Image size 2212x1659:
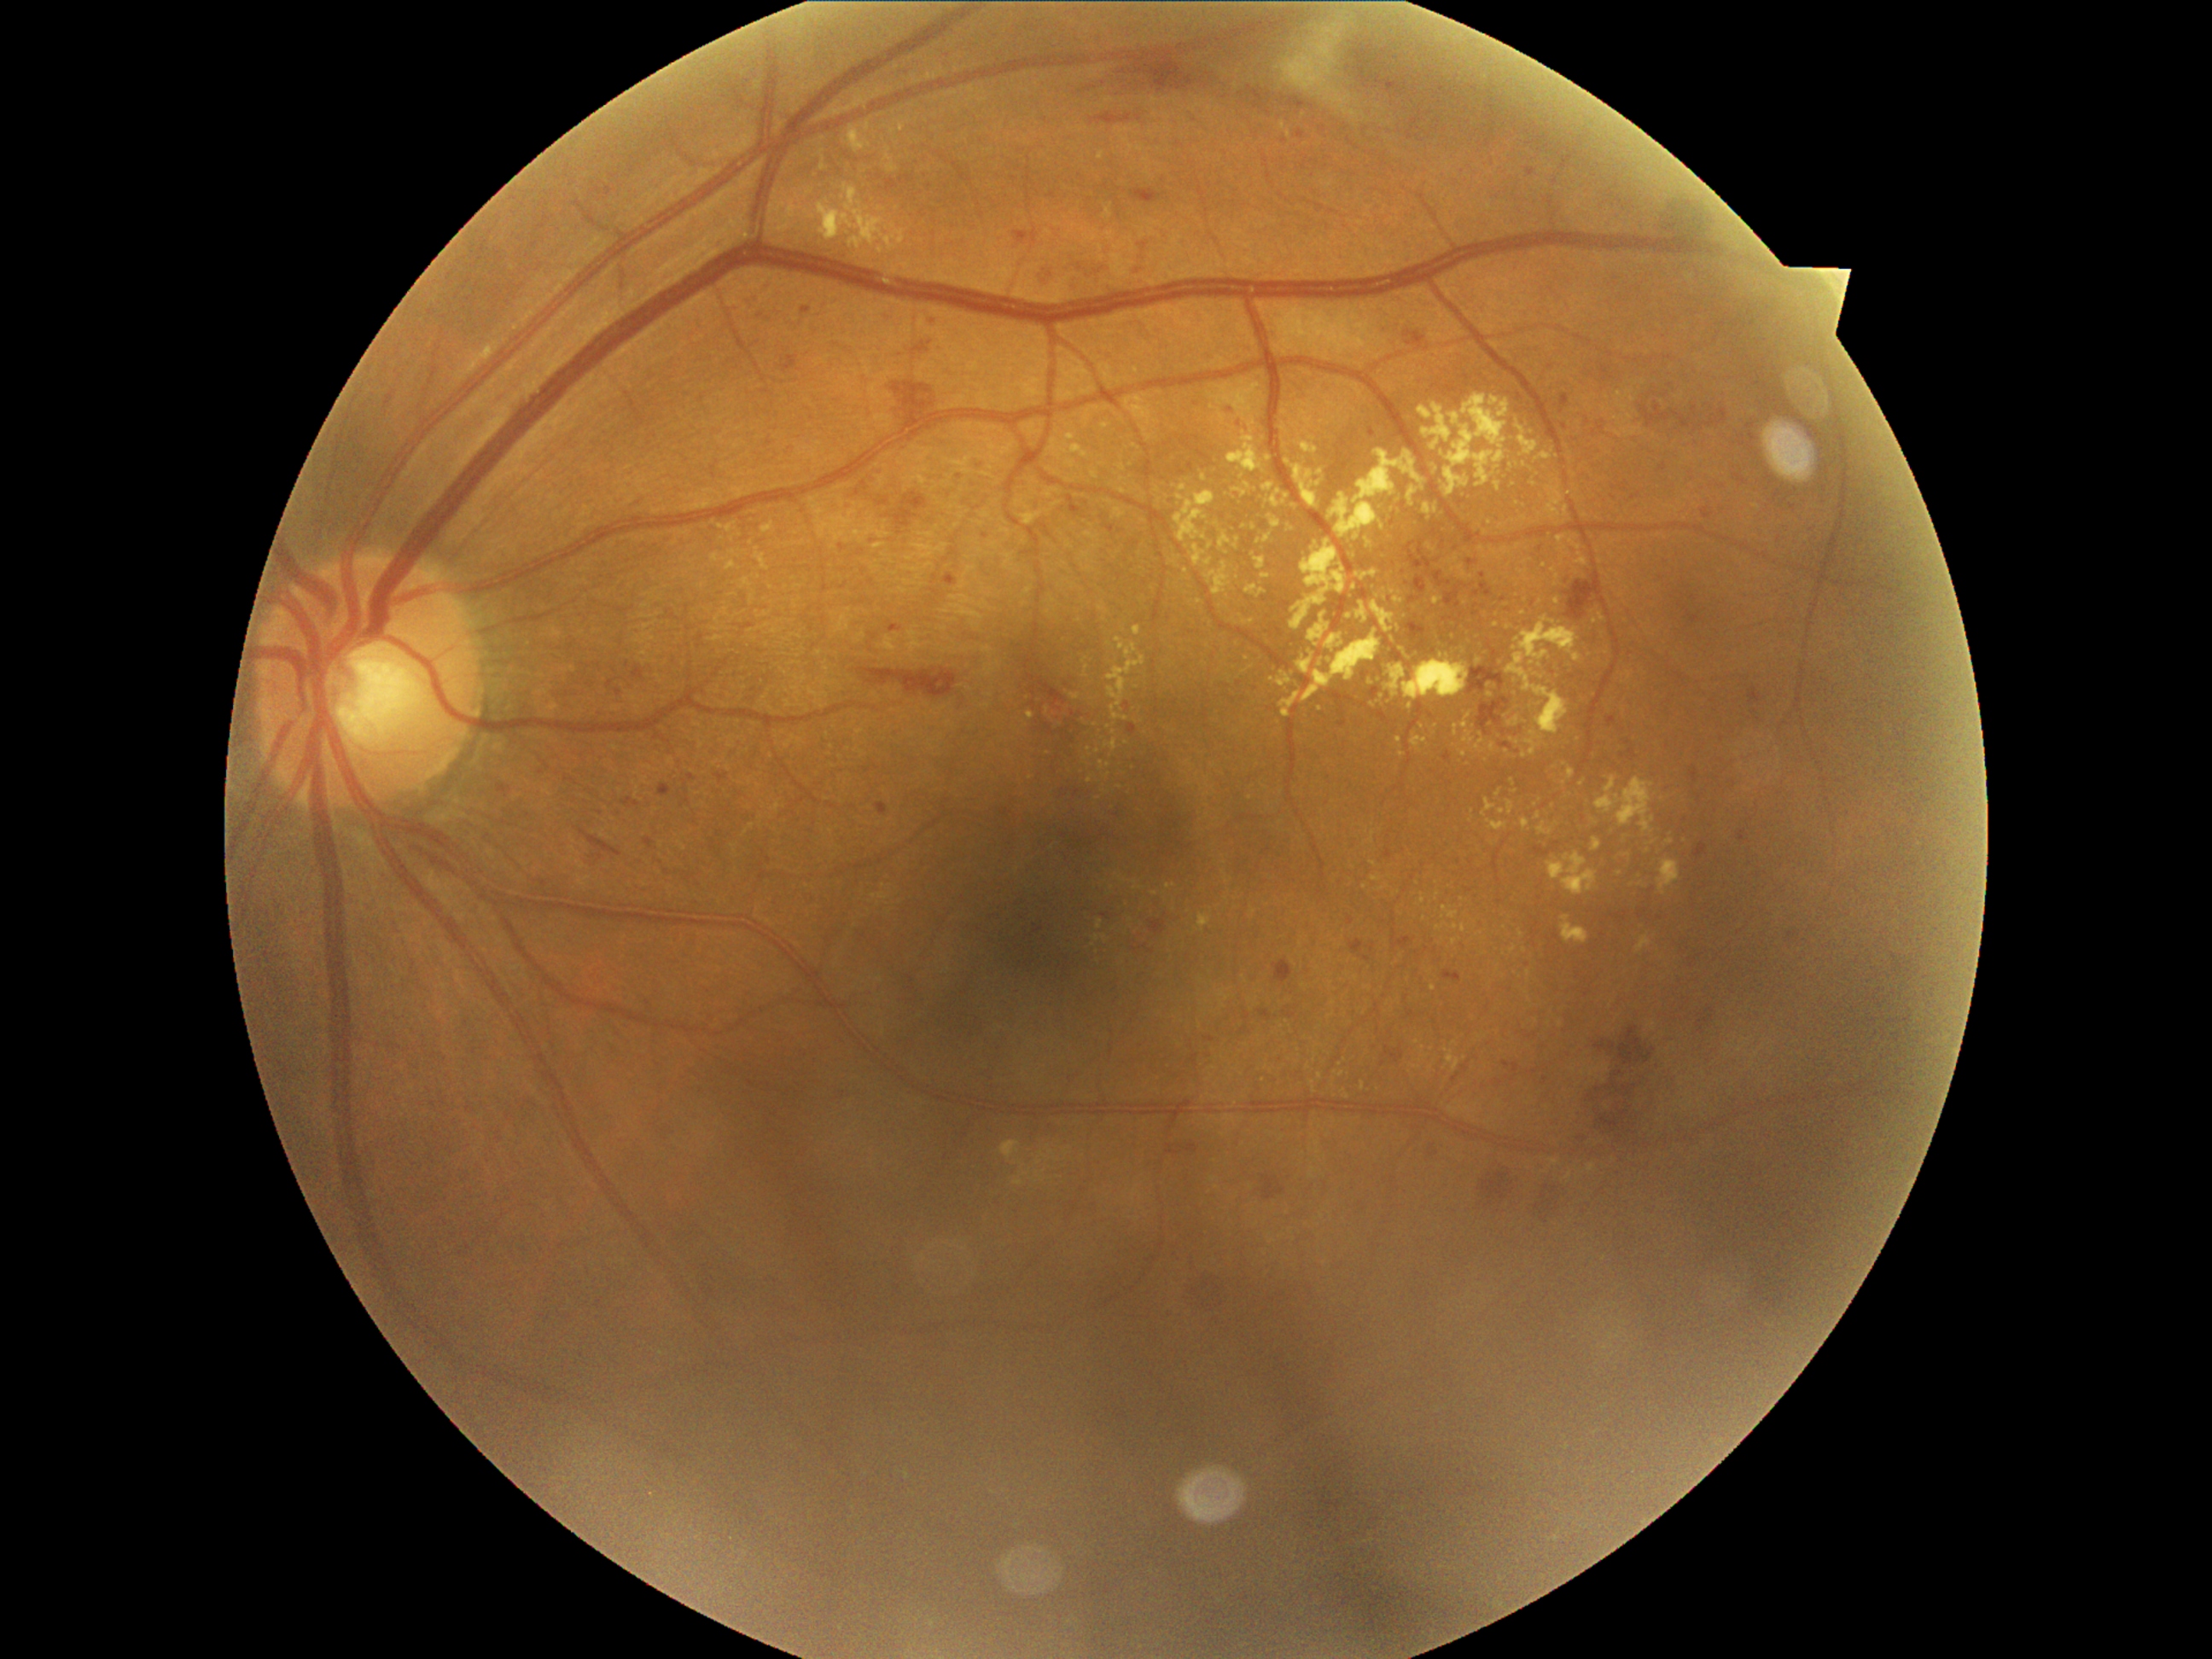

Diabetic retinopathy (DR): 2. Hard exudates (EXs) include those at {"x1": 1069, "y1": 446, "x2": 1090, "y2": 460} | {"x1": 1501, "y1": 547, "x2": 1513, "y2": 556} | {"x1": 1371, "y1": 875, "x2": 1382, "y2": 882} | {"x1": 1556, "y1": 535, "x2": 1566, "y2": 544} | {"x1": 1252, "y1": 554, "x2": 1266, "y2": 569} | {"x1": 1134, "y1": 887, "x2": 1143, "y2": 890} | {"x1": 1404, "y1": 655, "x2": 1419, "y2": 665} | {"x1": 1545, "y1": 487, "x2": 1564, "y2": 520} | {"x1": 1402, "y1": 660, "x2": 1470, "y2": 701} | {"x1": 1460, "y1": 750, "x2": 1467, "y2": 759}. Additional small EXs near x=1350 y=617 | x=1514 y=793 | x=1561 y=1024 | x=1433 y=588 | x=1312 y=1084 | x=1519 y=546 | x=1085 y=676 | x=1127 y=743 | x=1513 y=949.